2228 x 1652 pixels, dilated-pupil acquisition
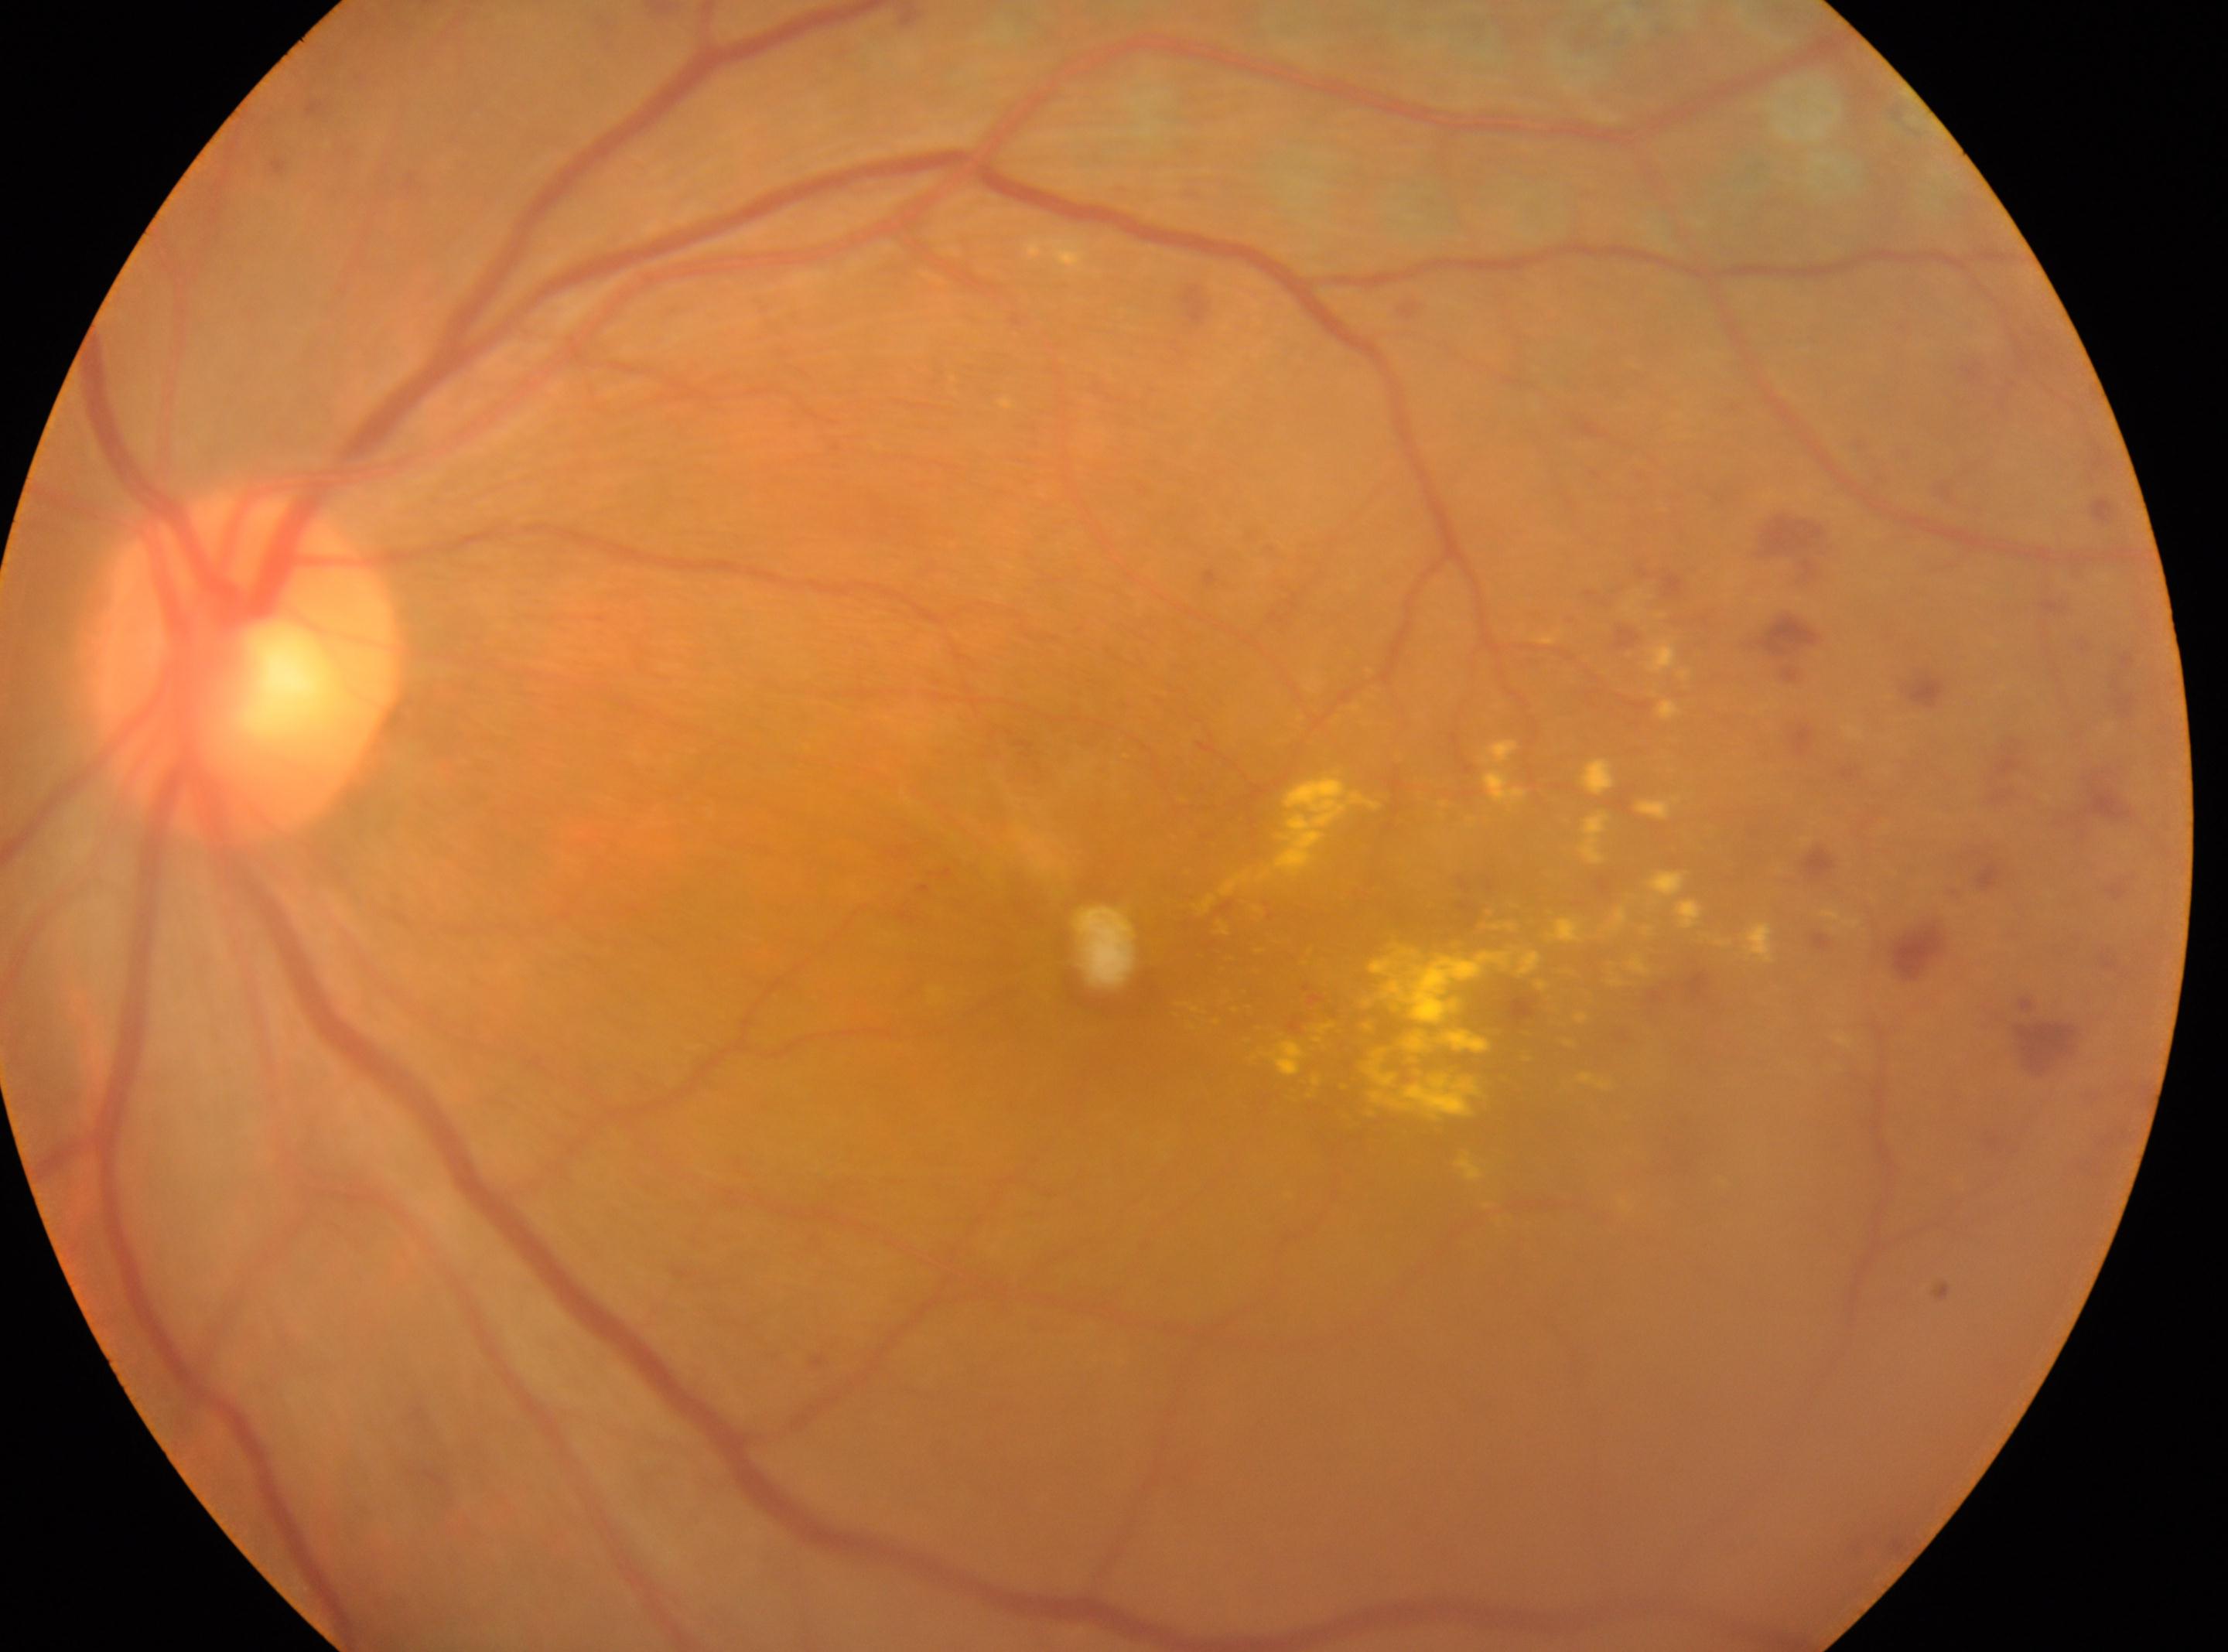 Annotations:
• macular center: (x=1119, y=948)
• optic disk: (x=246, y=668)
• laterality: oculus sinister
• diabetic retinopathy severity: DR with laser photocoagulation scars, underlying severity grade 4 (PDR)